1536x1152px.
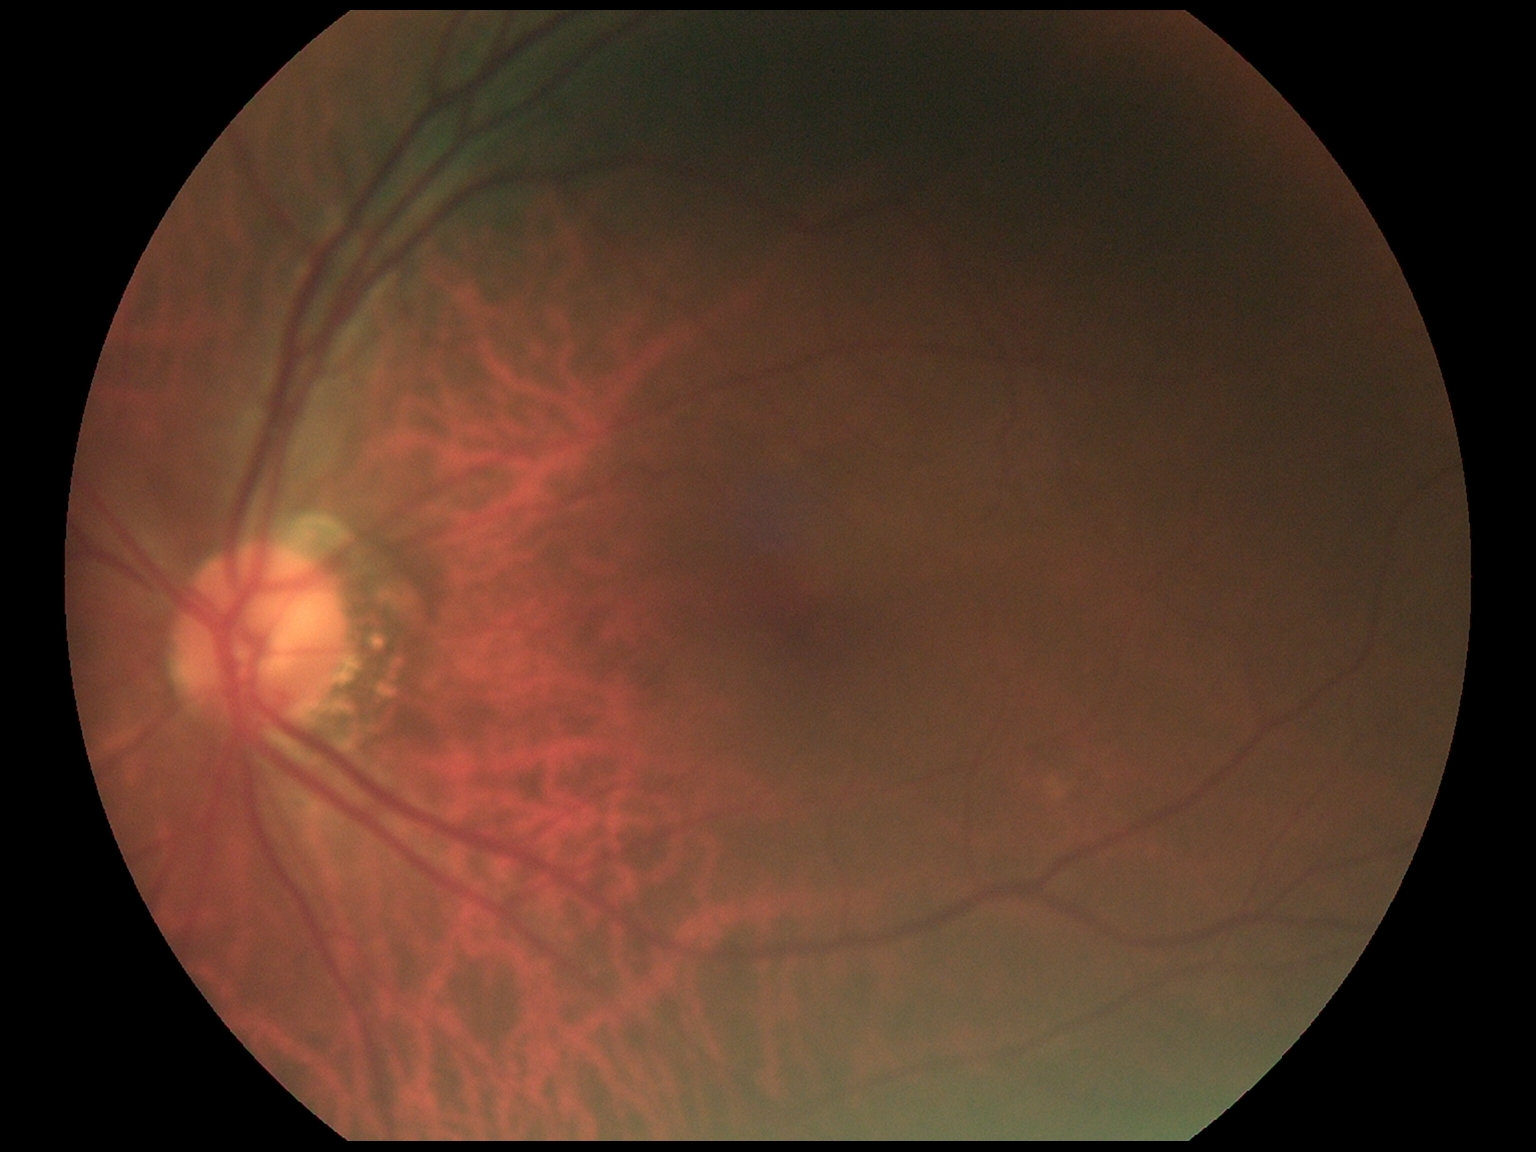

No signs of diabetic retinopathy.
DR stage is grade 0 (no apparent retinopathy).